Image size 2352x1568:
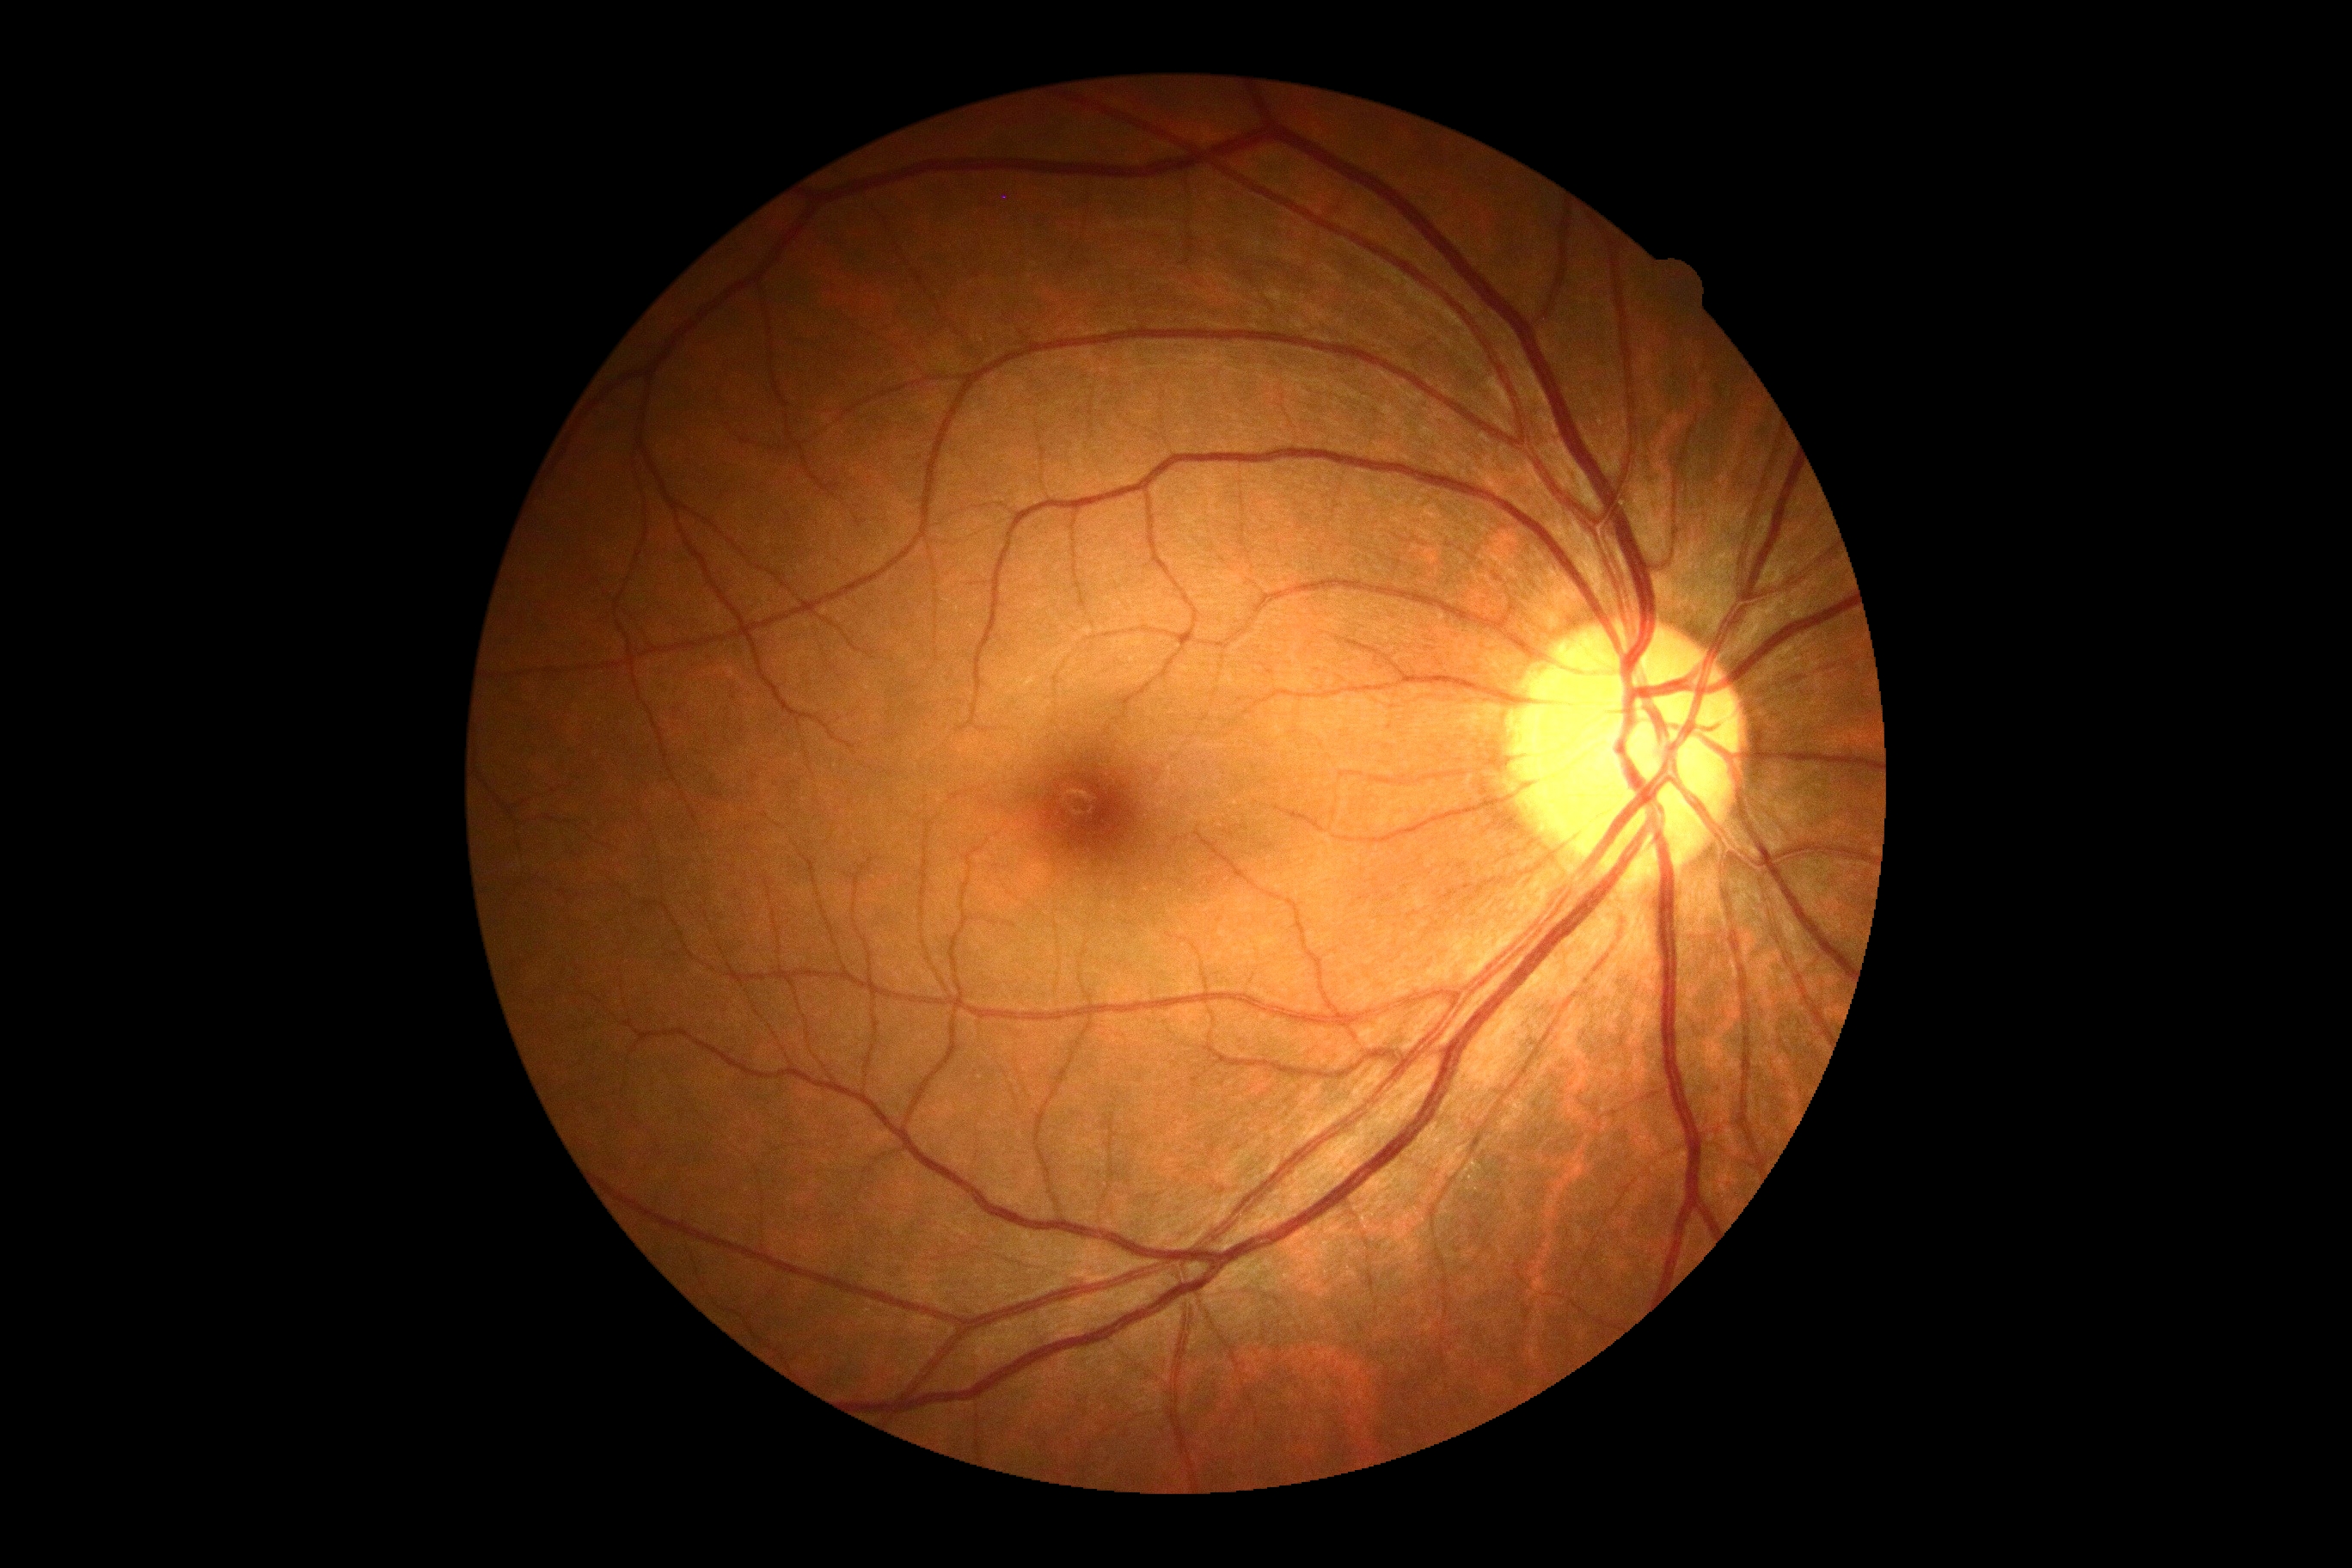

diabetic retinopathy=grade 0 (no apparent retinopathy); DR impression=negative for DR.